45° field of view:
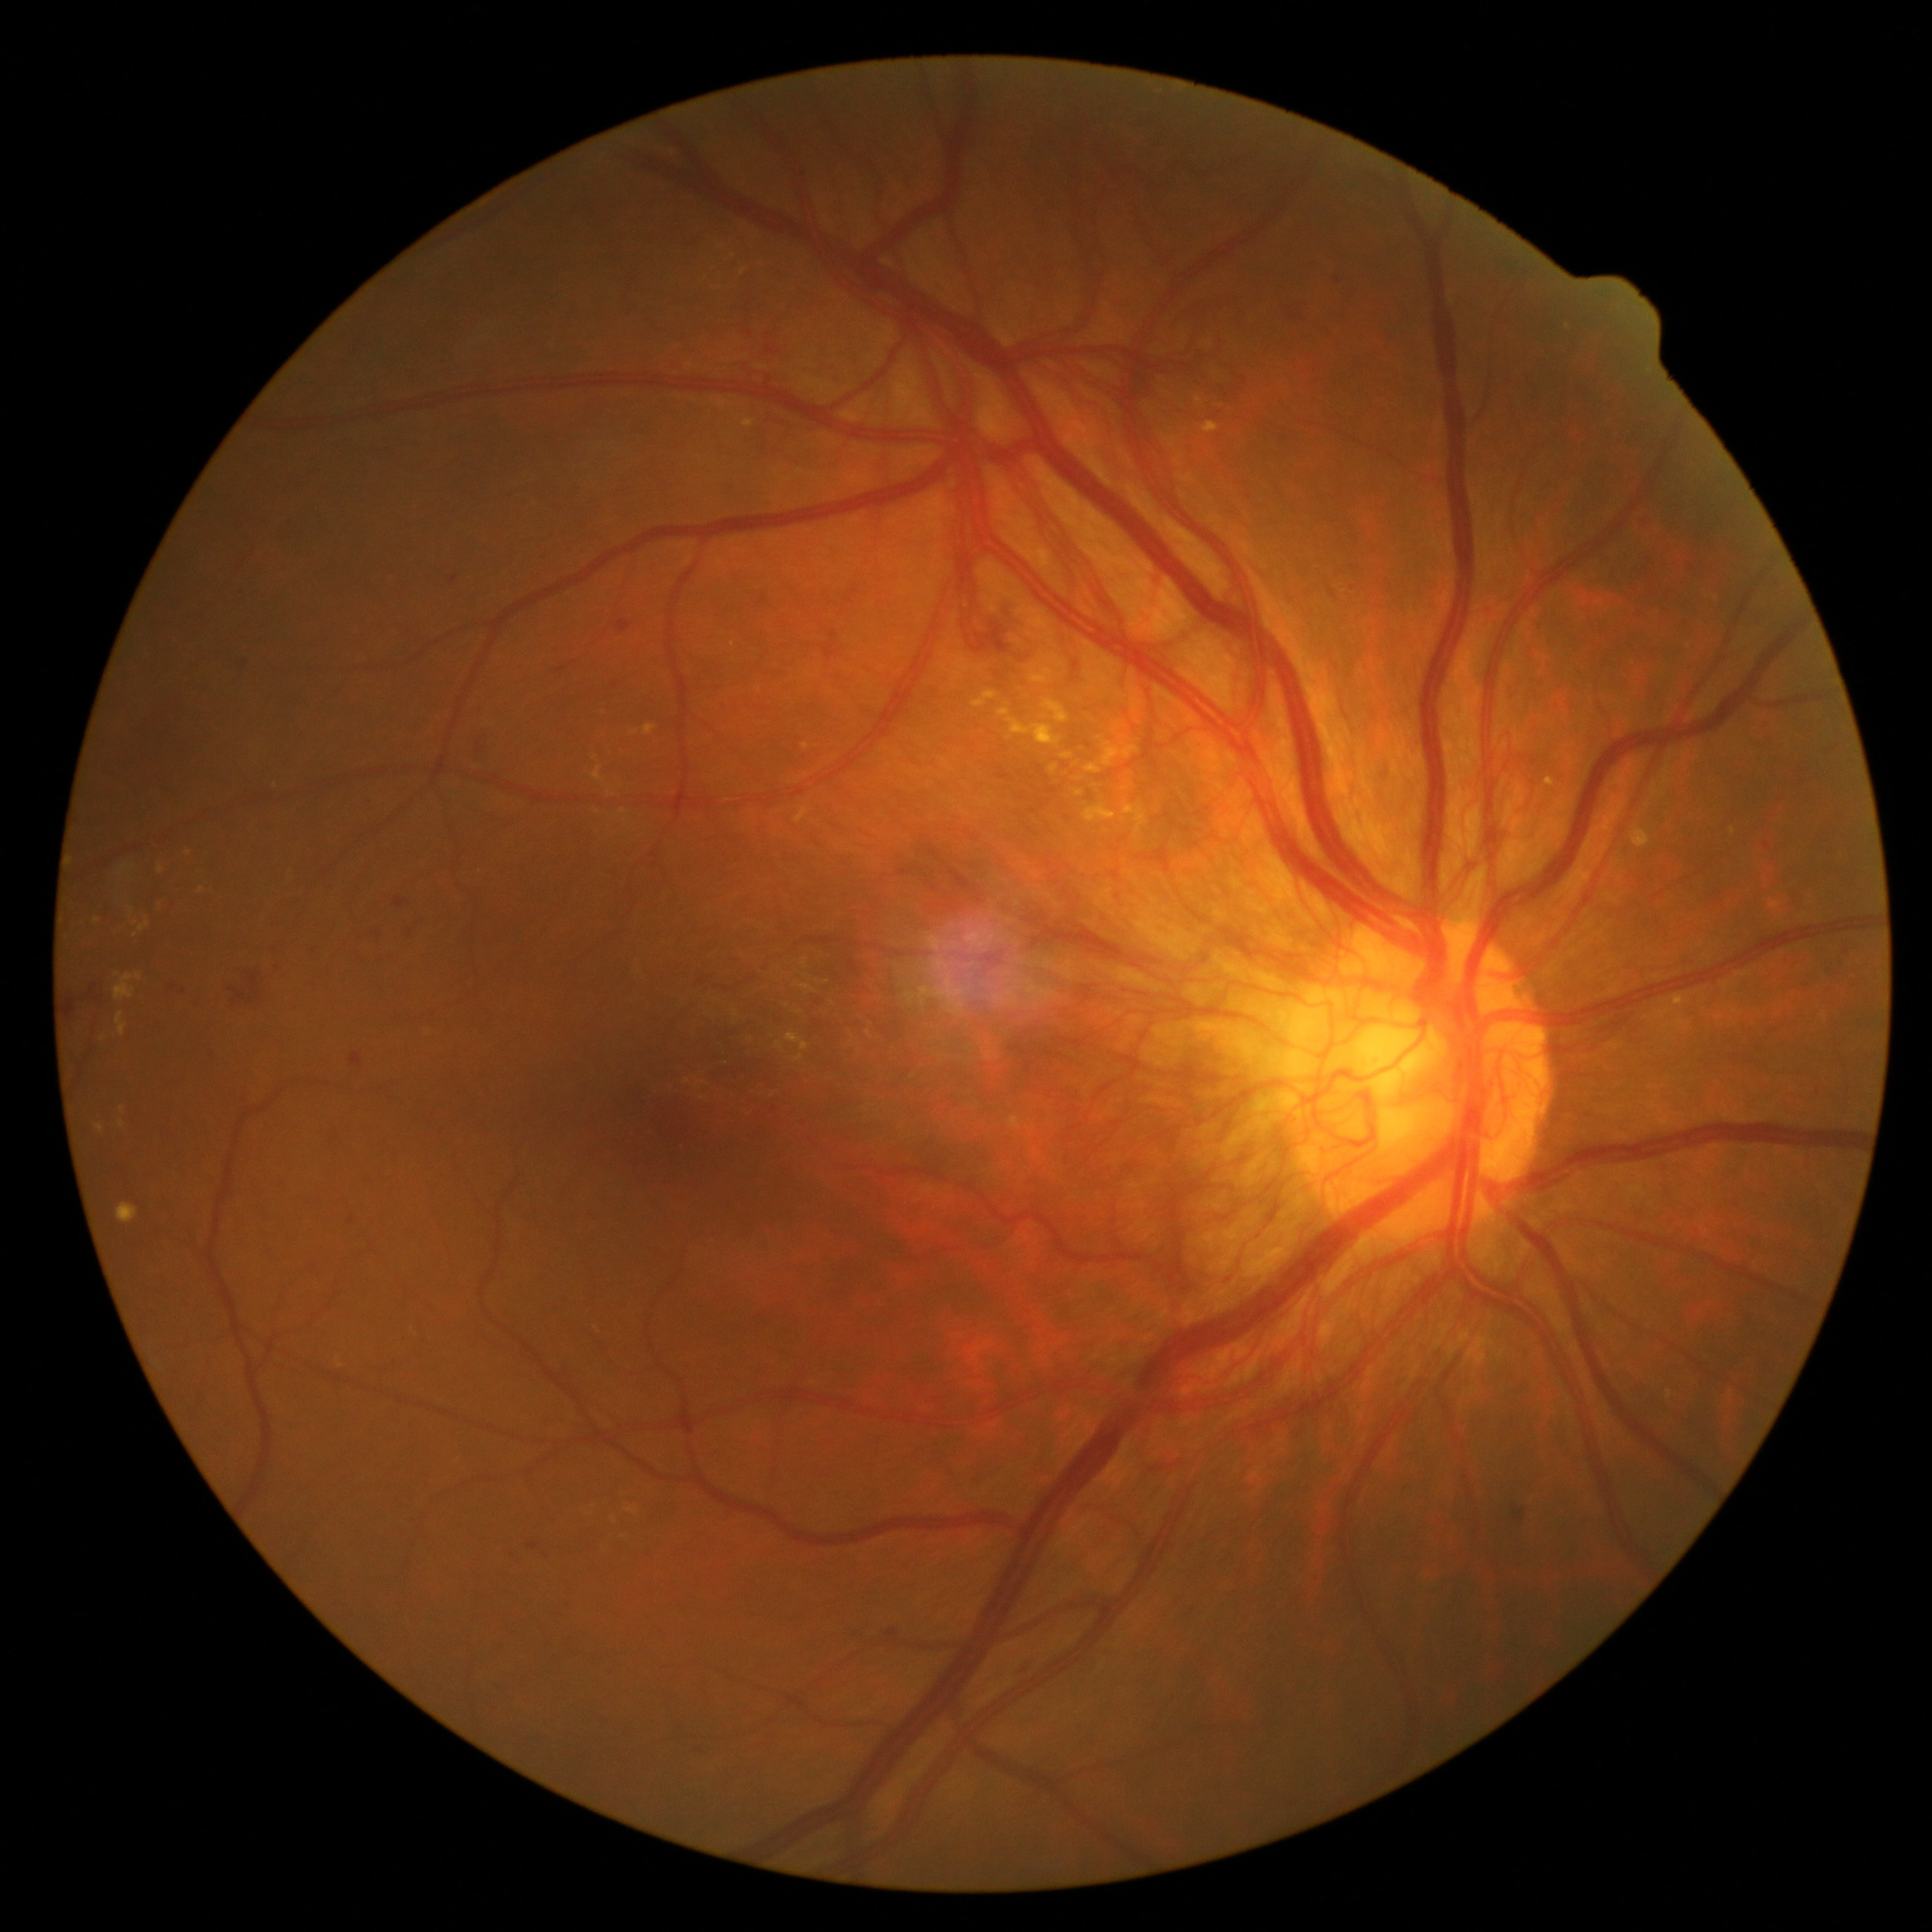
Diabetic retinopathy (DR) is 4/4
Selected lesions:
hard exudates (EXs) (continued): 1084/804/1116/822; 794/806/809/822; 972/692/998/707; 96/1124/105/1133; 135/973/143/982; 119/865/129/876; 1098/736/1140/766; 643/725/658/736
Small EXs near (122; 1109); (806; 746); (201; 890); (275; 785); (612; 795); (96; 920)
hemorrhages (HEs) (continued): 886/1628/898/1645; 347/1216/356/1225; 394/897/409/908; 1291/312/1305/319; 611/683/619/689; 406/929/413/937; 229/971/261/1006; 615/619/631/633; 1715/899/1723/905; 1764/842/1770/851; 1016/1658/1039/1678
Small HEs near (546; 1557); (1832; 752); (184; 992)